Image size 1659x2212:
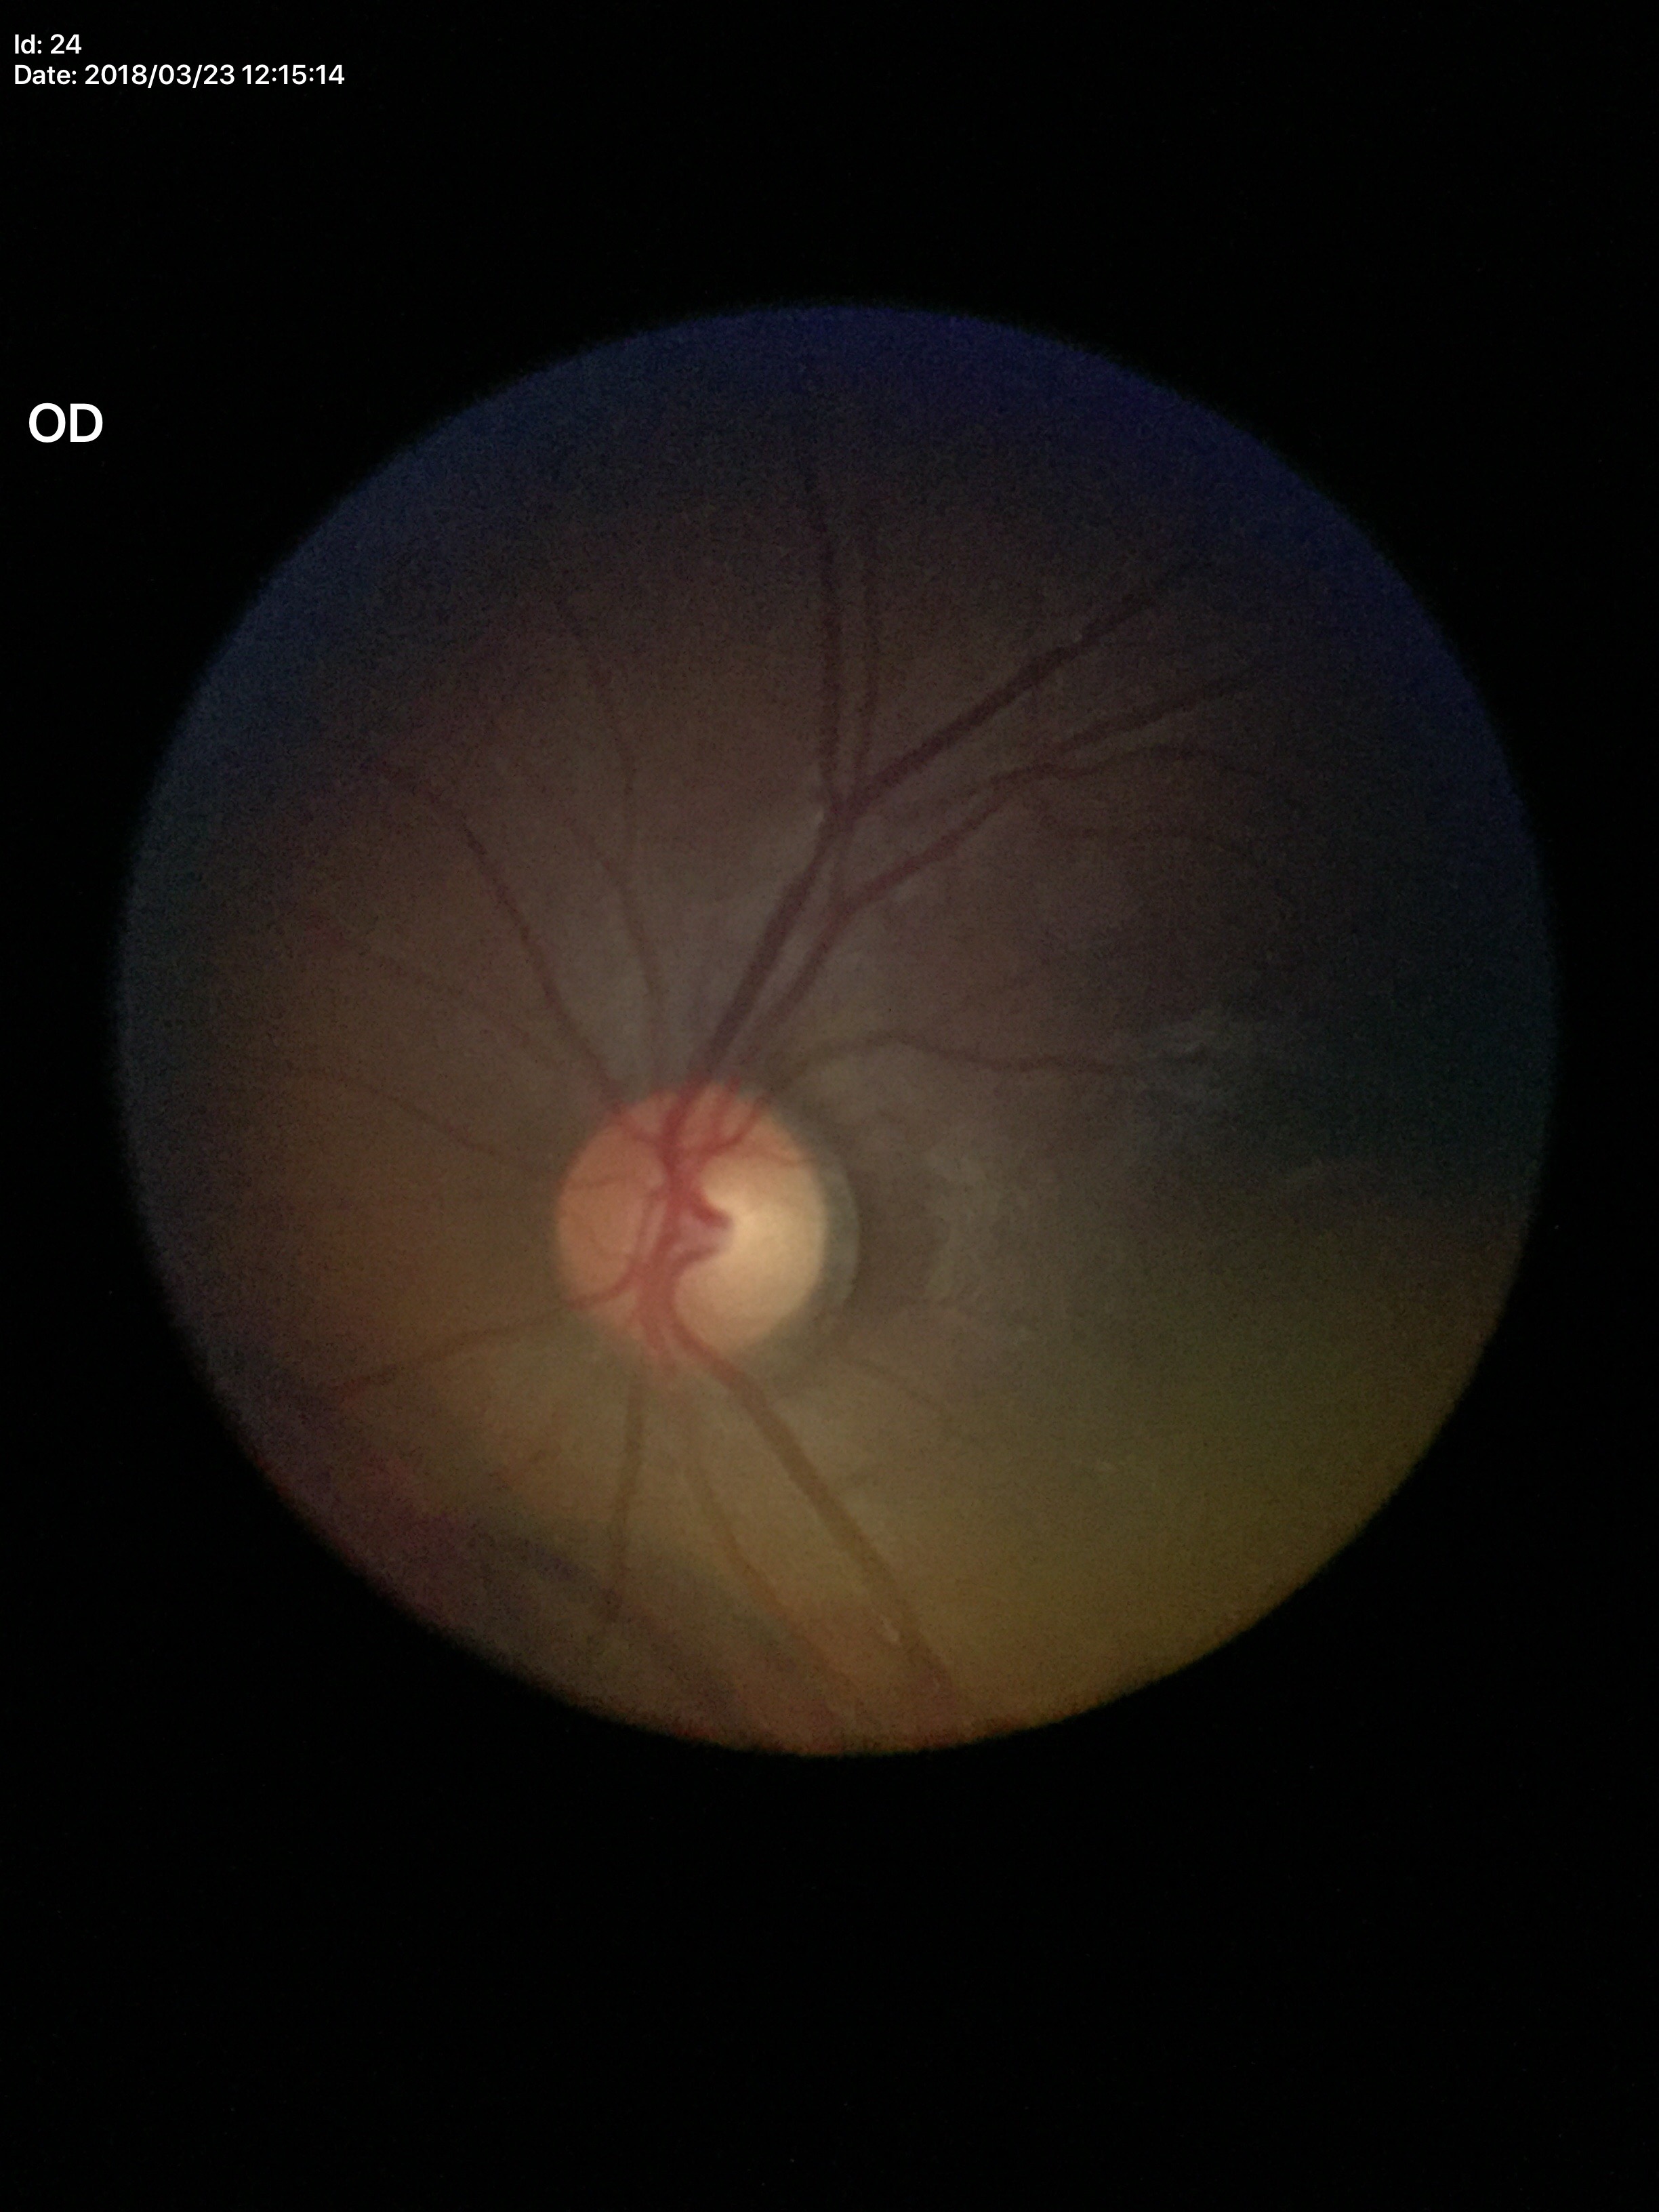

Vertical C/D ratio is 0.52.
Negative for glaucoma suspicion.